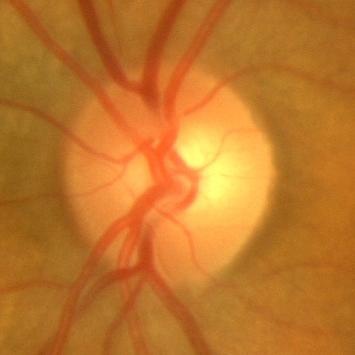

Showing no glaucomatous findings.